640 by 480 pixels; camera: Clarity RetCam 3 (130° FOV); RetCam wide-field infant fundus image:
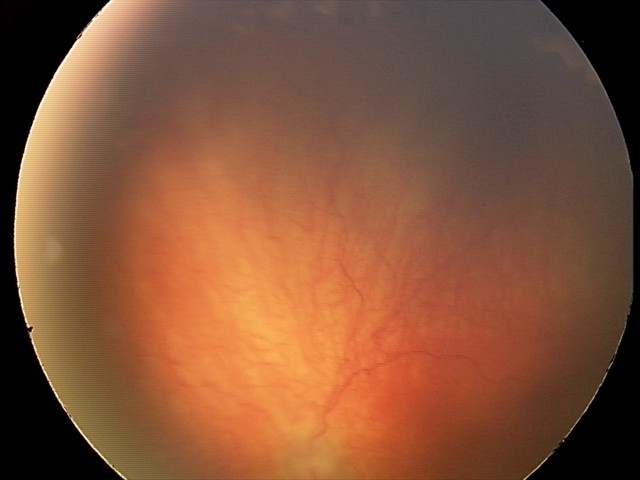

Screening examination consistent with aggressive retinopathy of prematurity — rapidly progressive severe ROP with prominent plus disease, often without classic stage progression. Plus disease present.